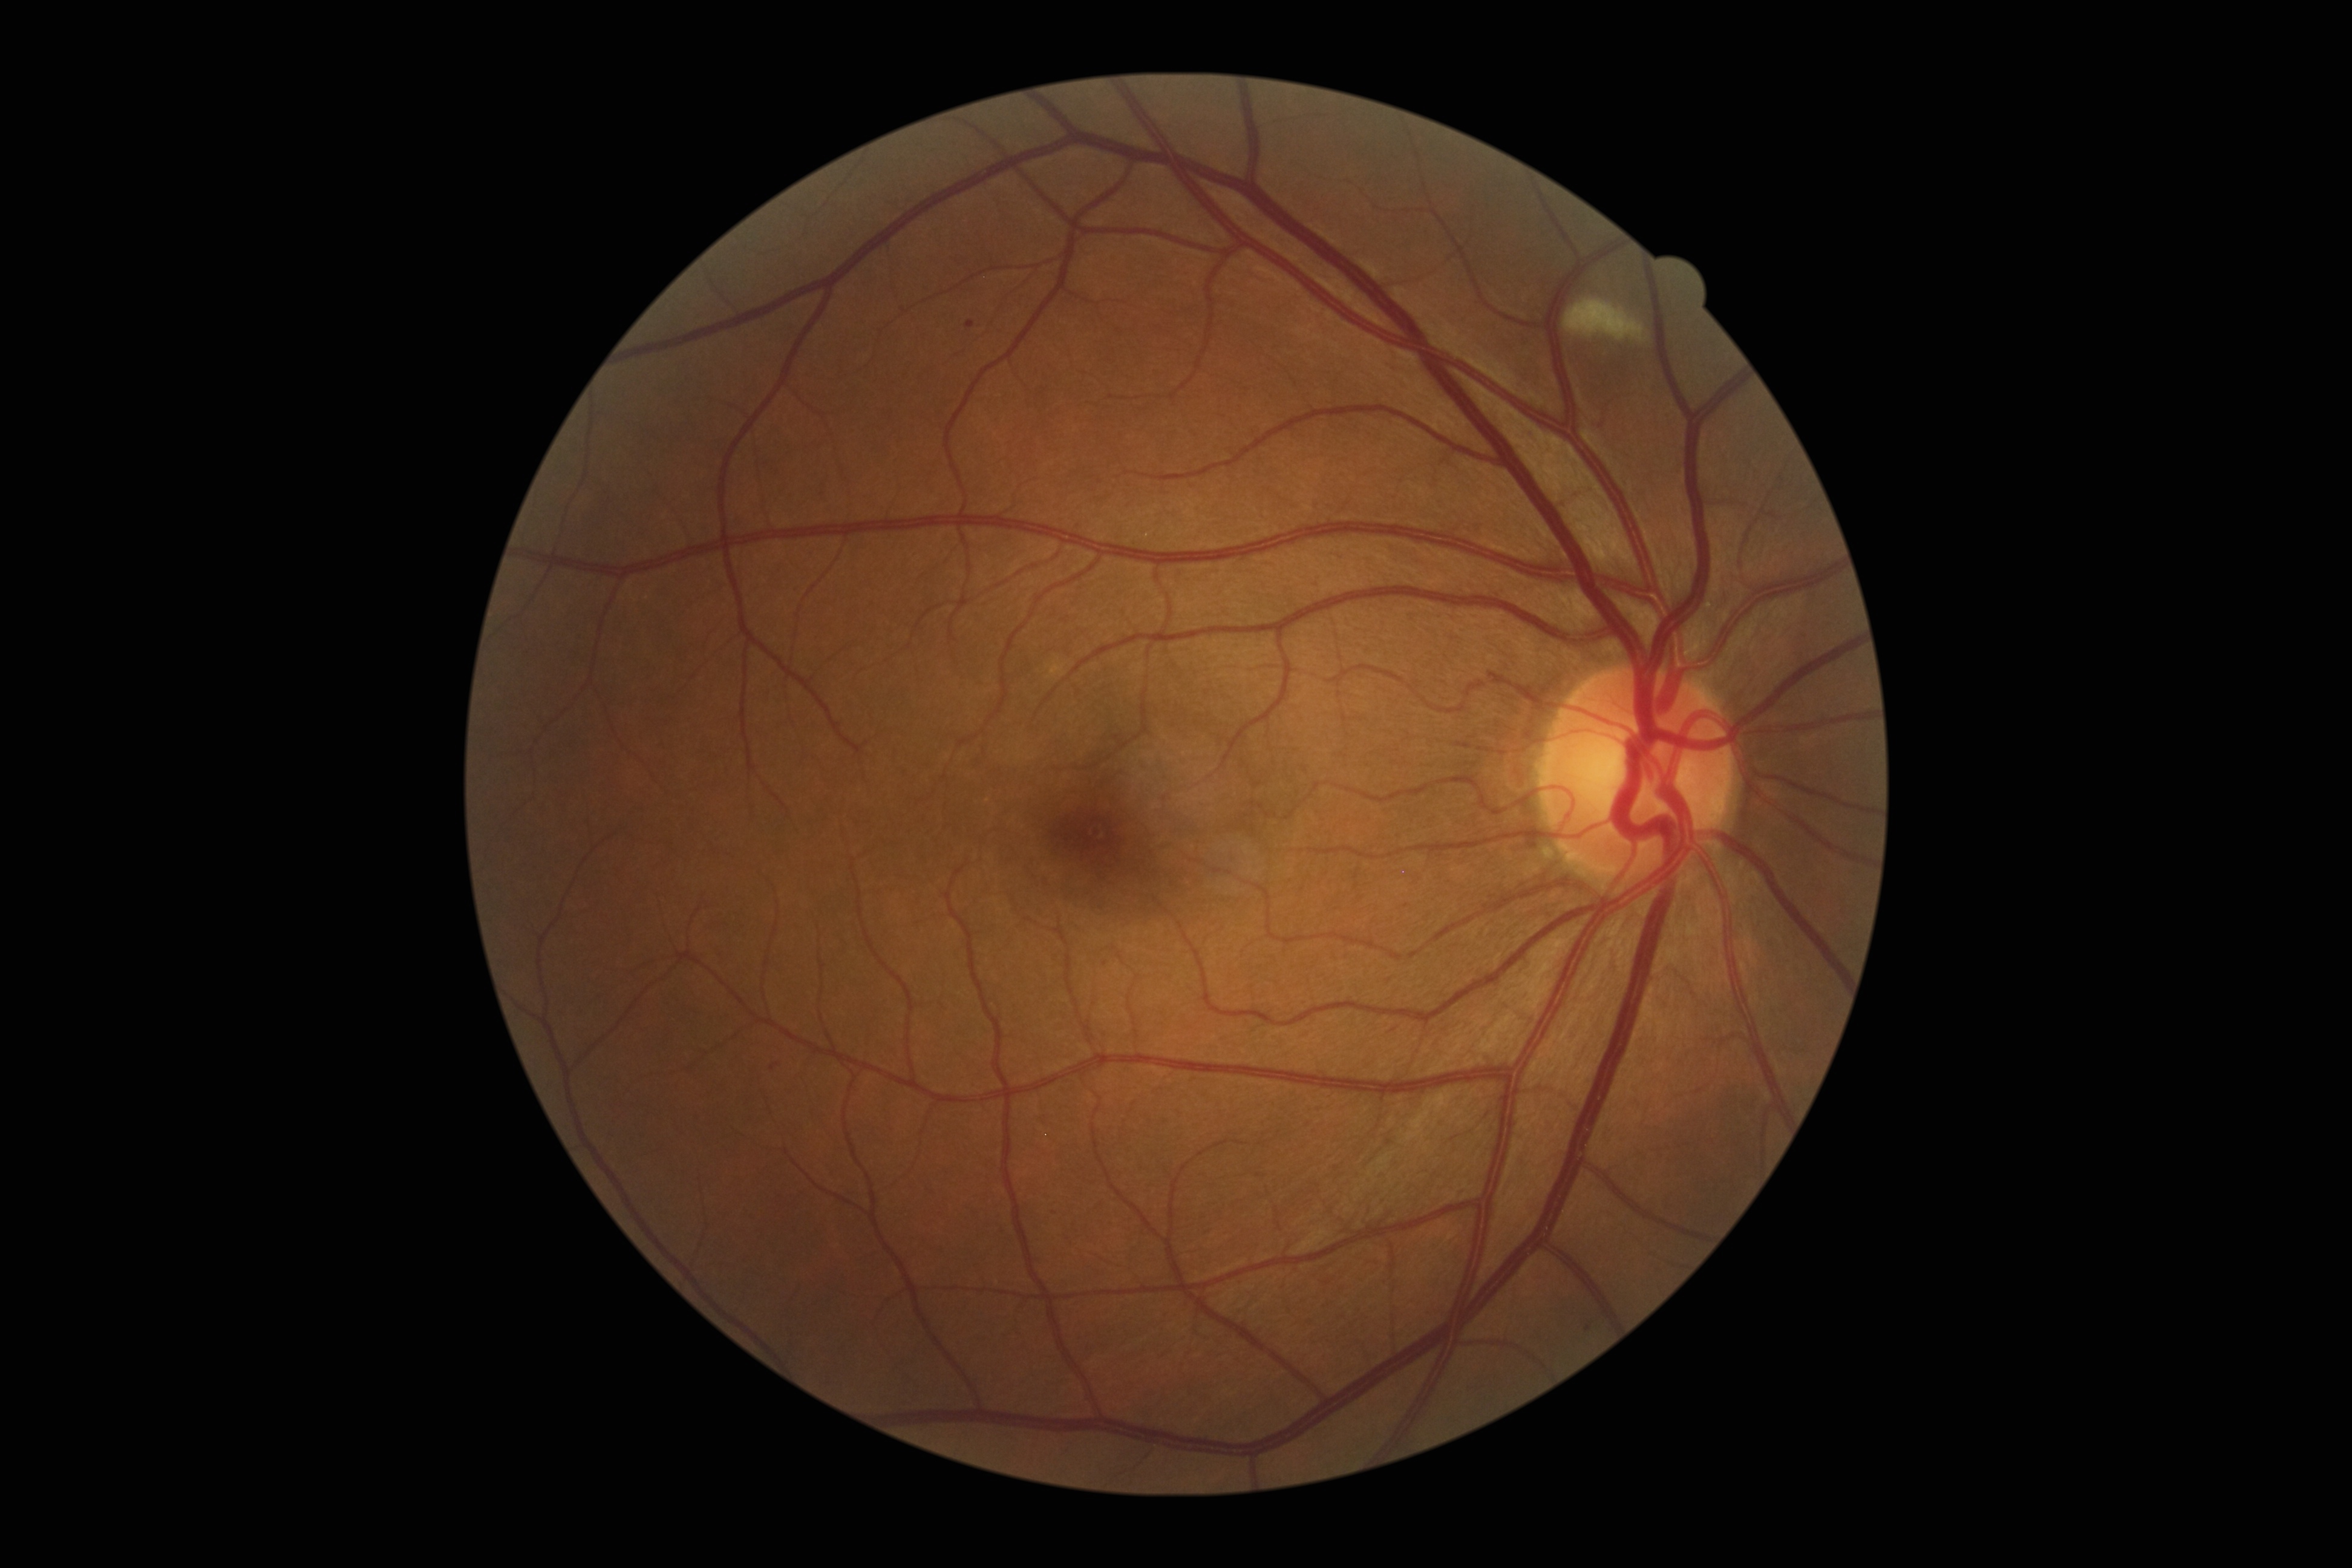
DR class: non-proliferative diabetic retinopathy. DR severity: 2.